Mydriatic (tropicamide 0.5%); 2361x1568px
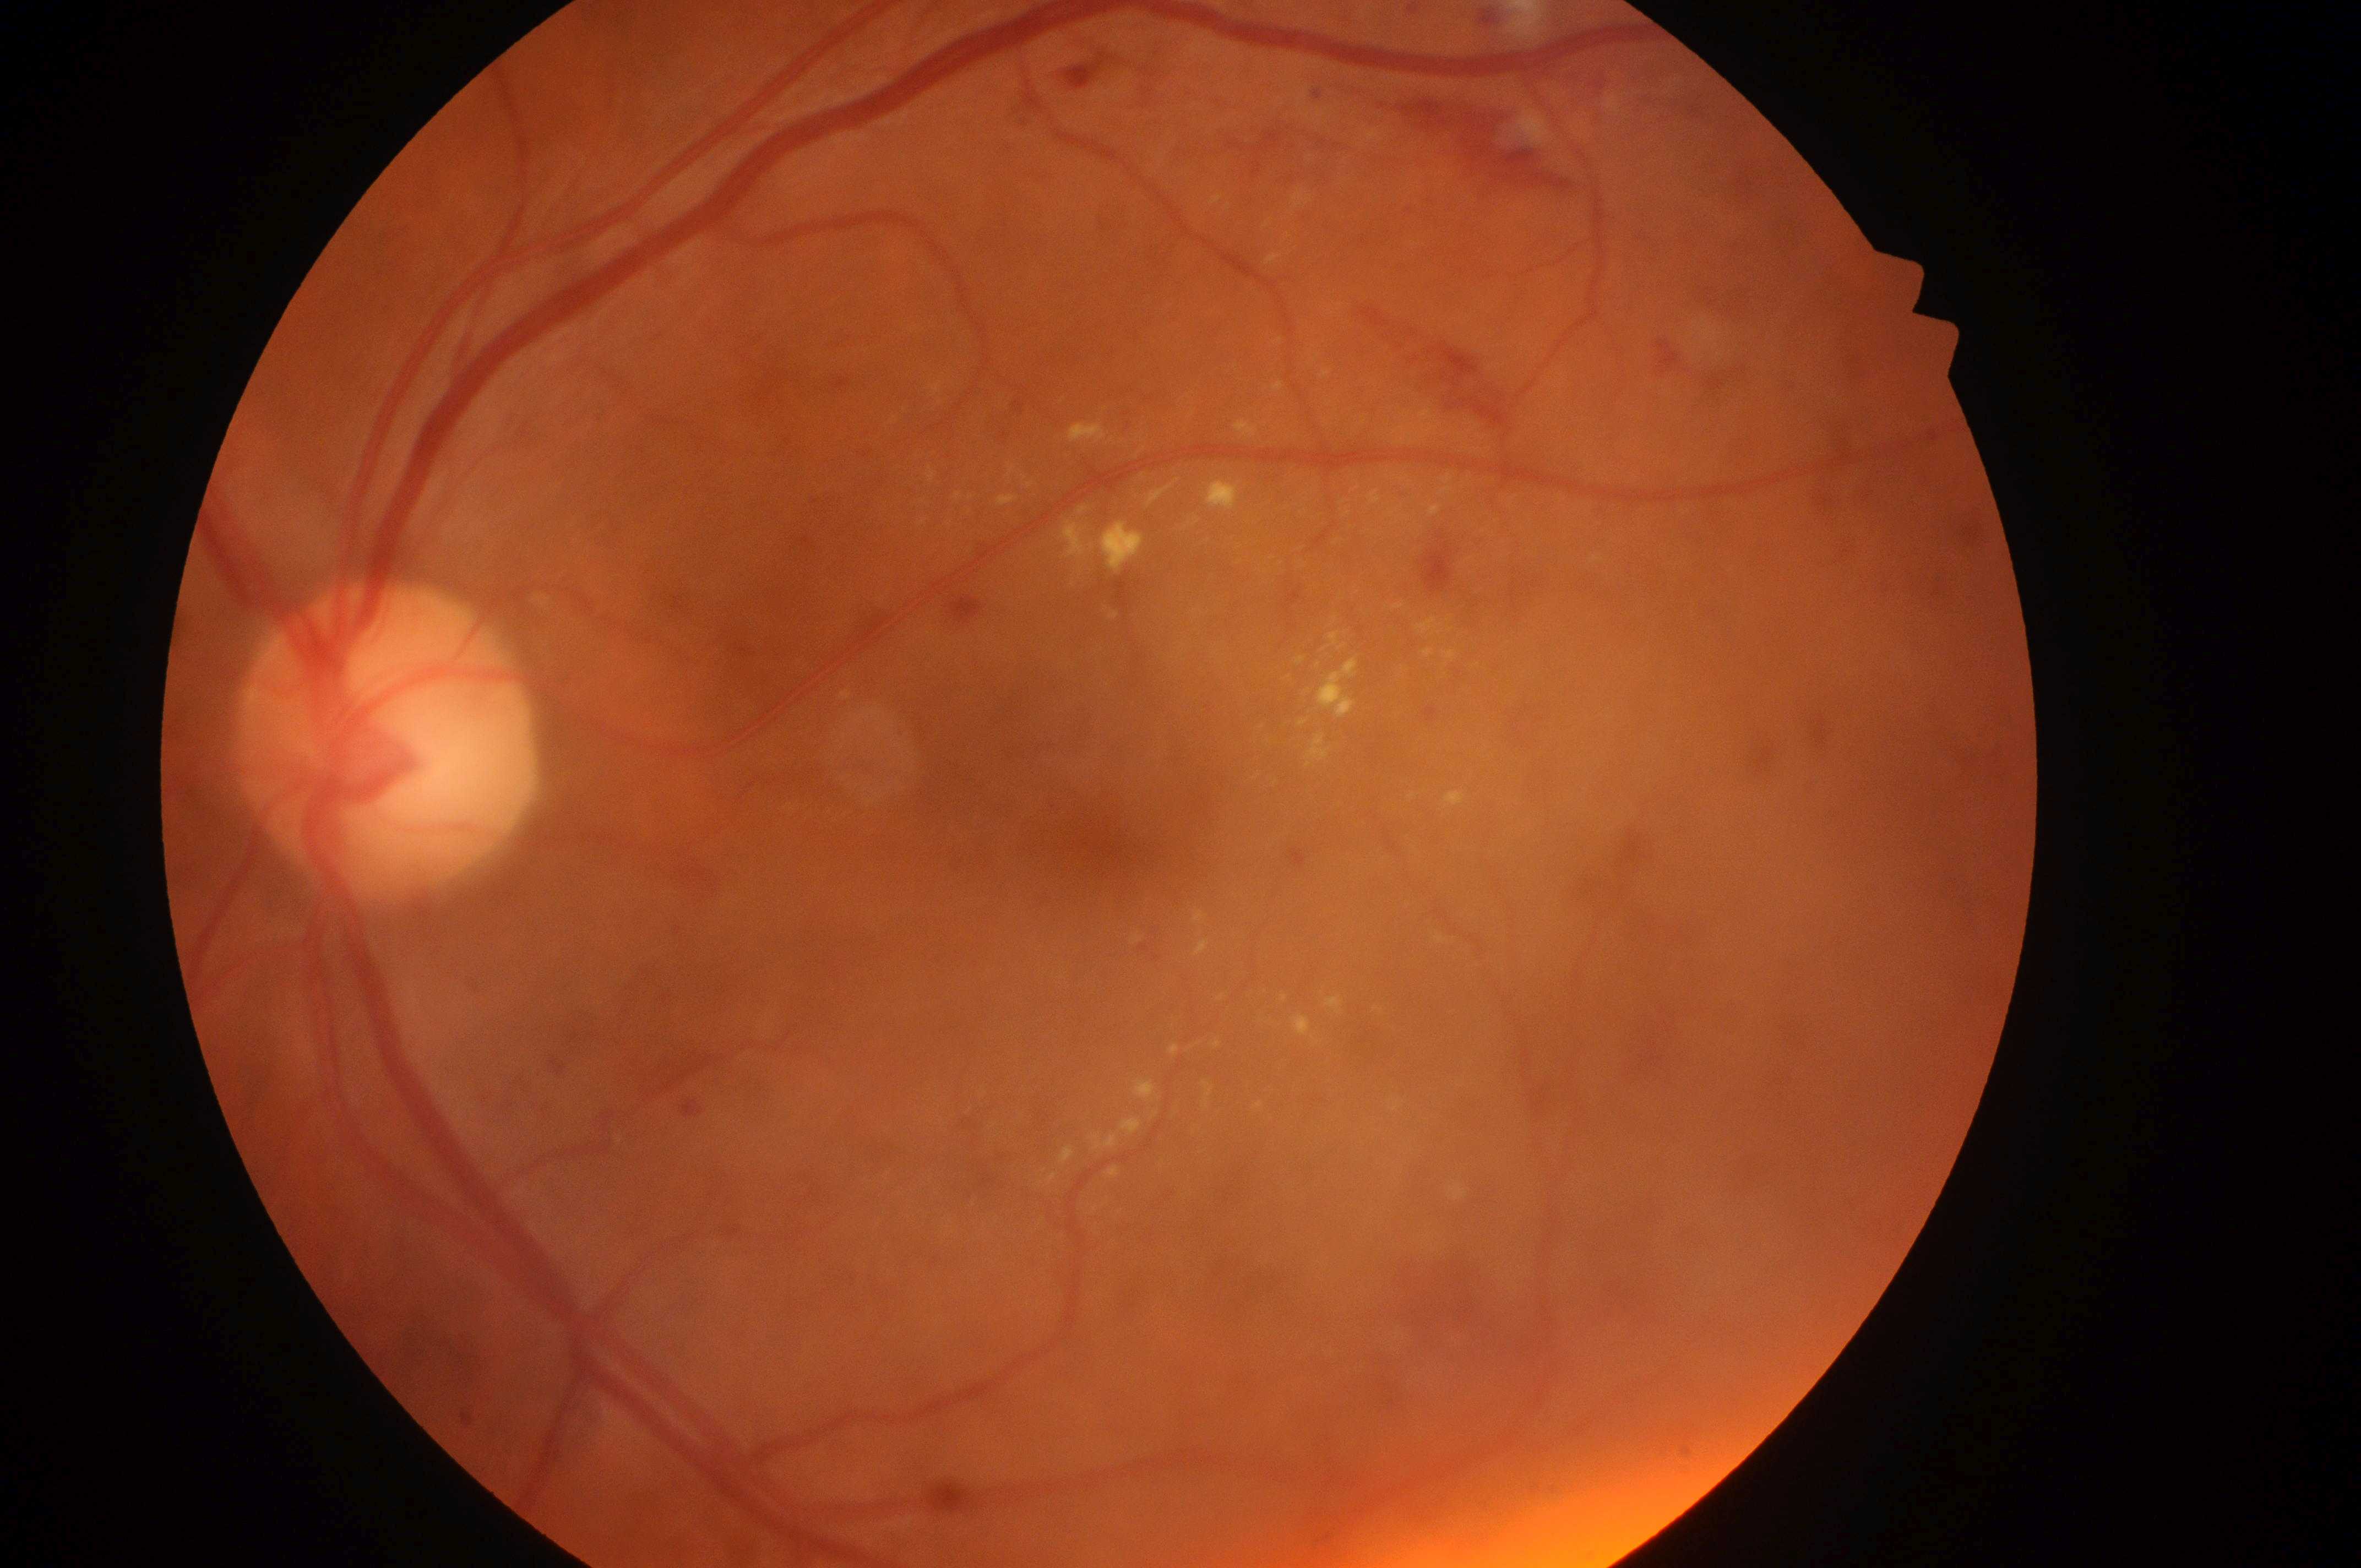

Diabetic macular edema (DME) is 2.
Fovea: (x=1116, y=850).
Eye: OS.
The disc center is at (x=381, y=748).
Diabetic retinopathy (DR) is grade 2.